2352x1568; FOV: 45 degrees; fundus photo.
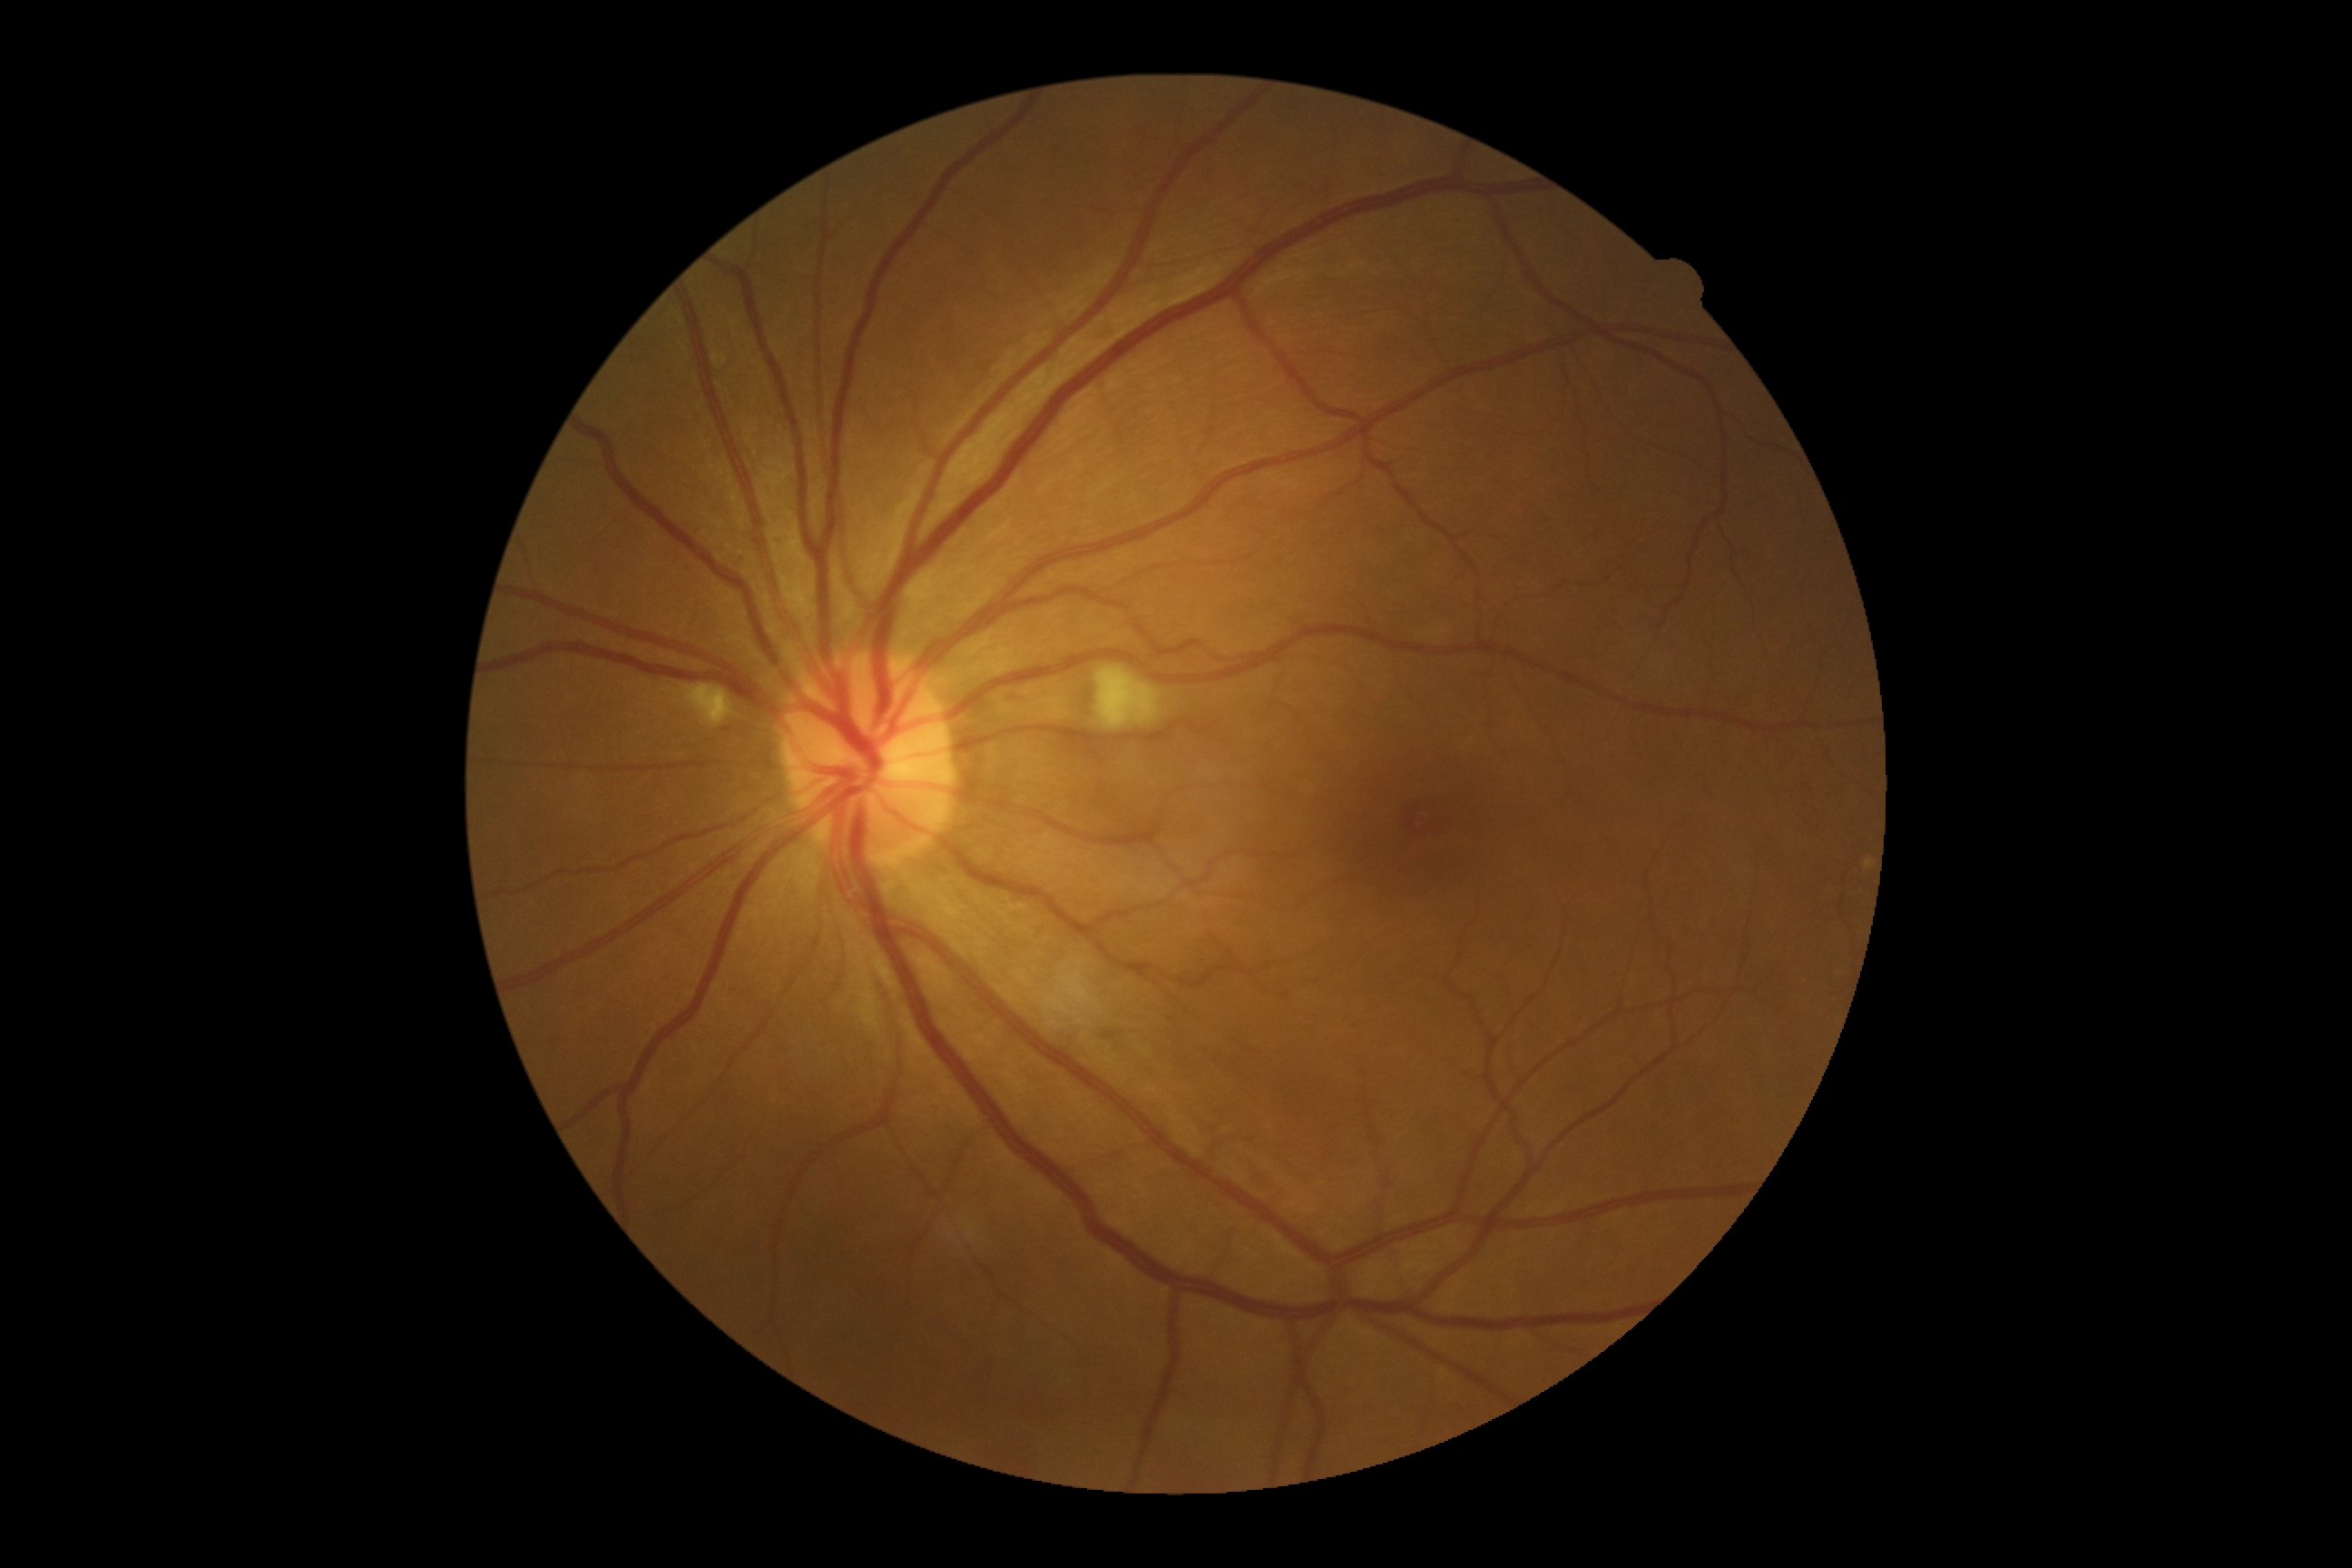

Diabetic retinopathy (DR): grade 2 (moderate NPDR).